Color fundus image:
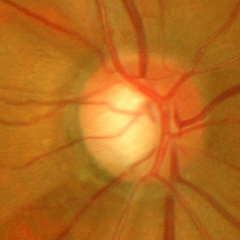
Early-stage glaucoma.